Modified Davis classification
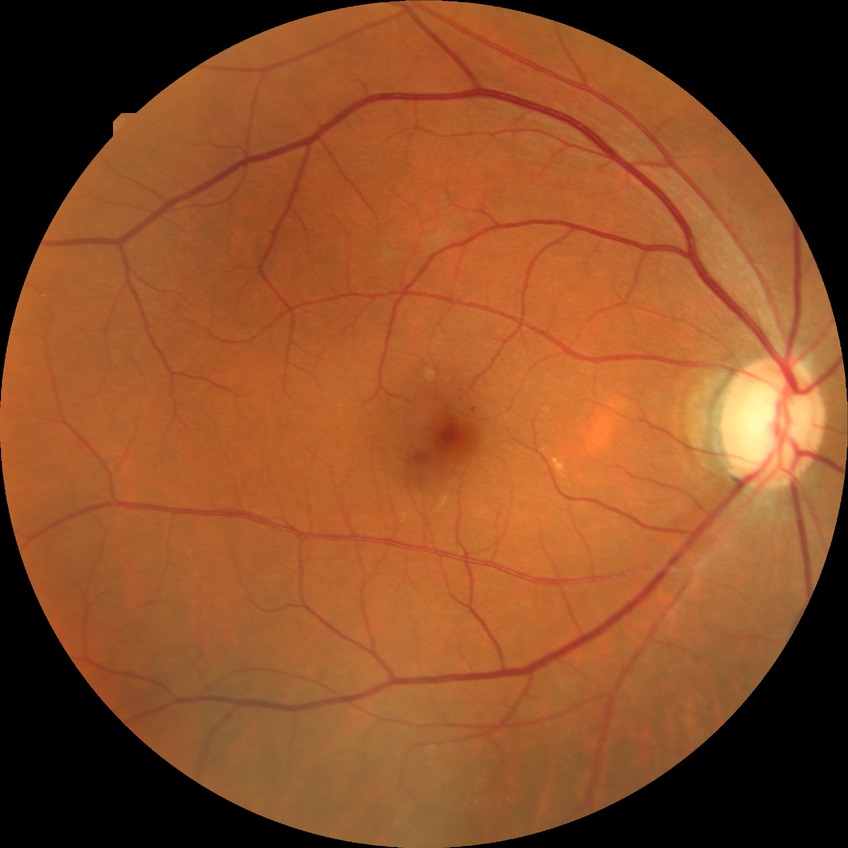
Diabetic retinopathy grade is simple diabetic retinopathy.